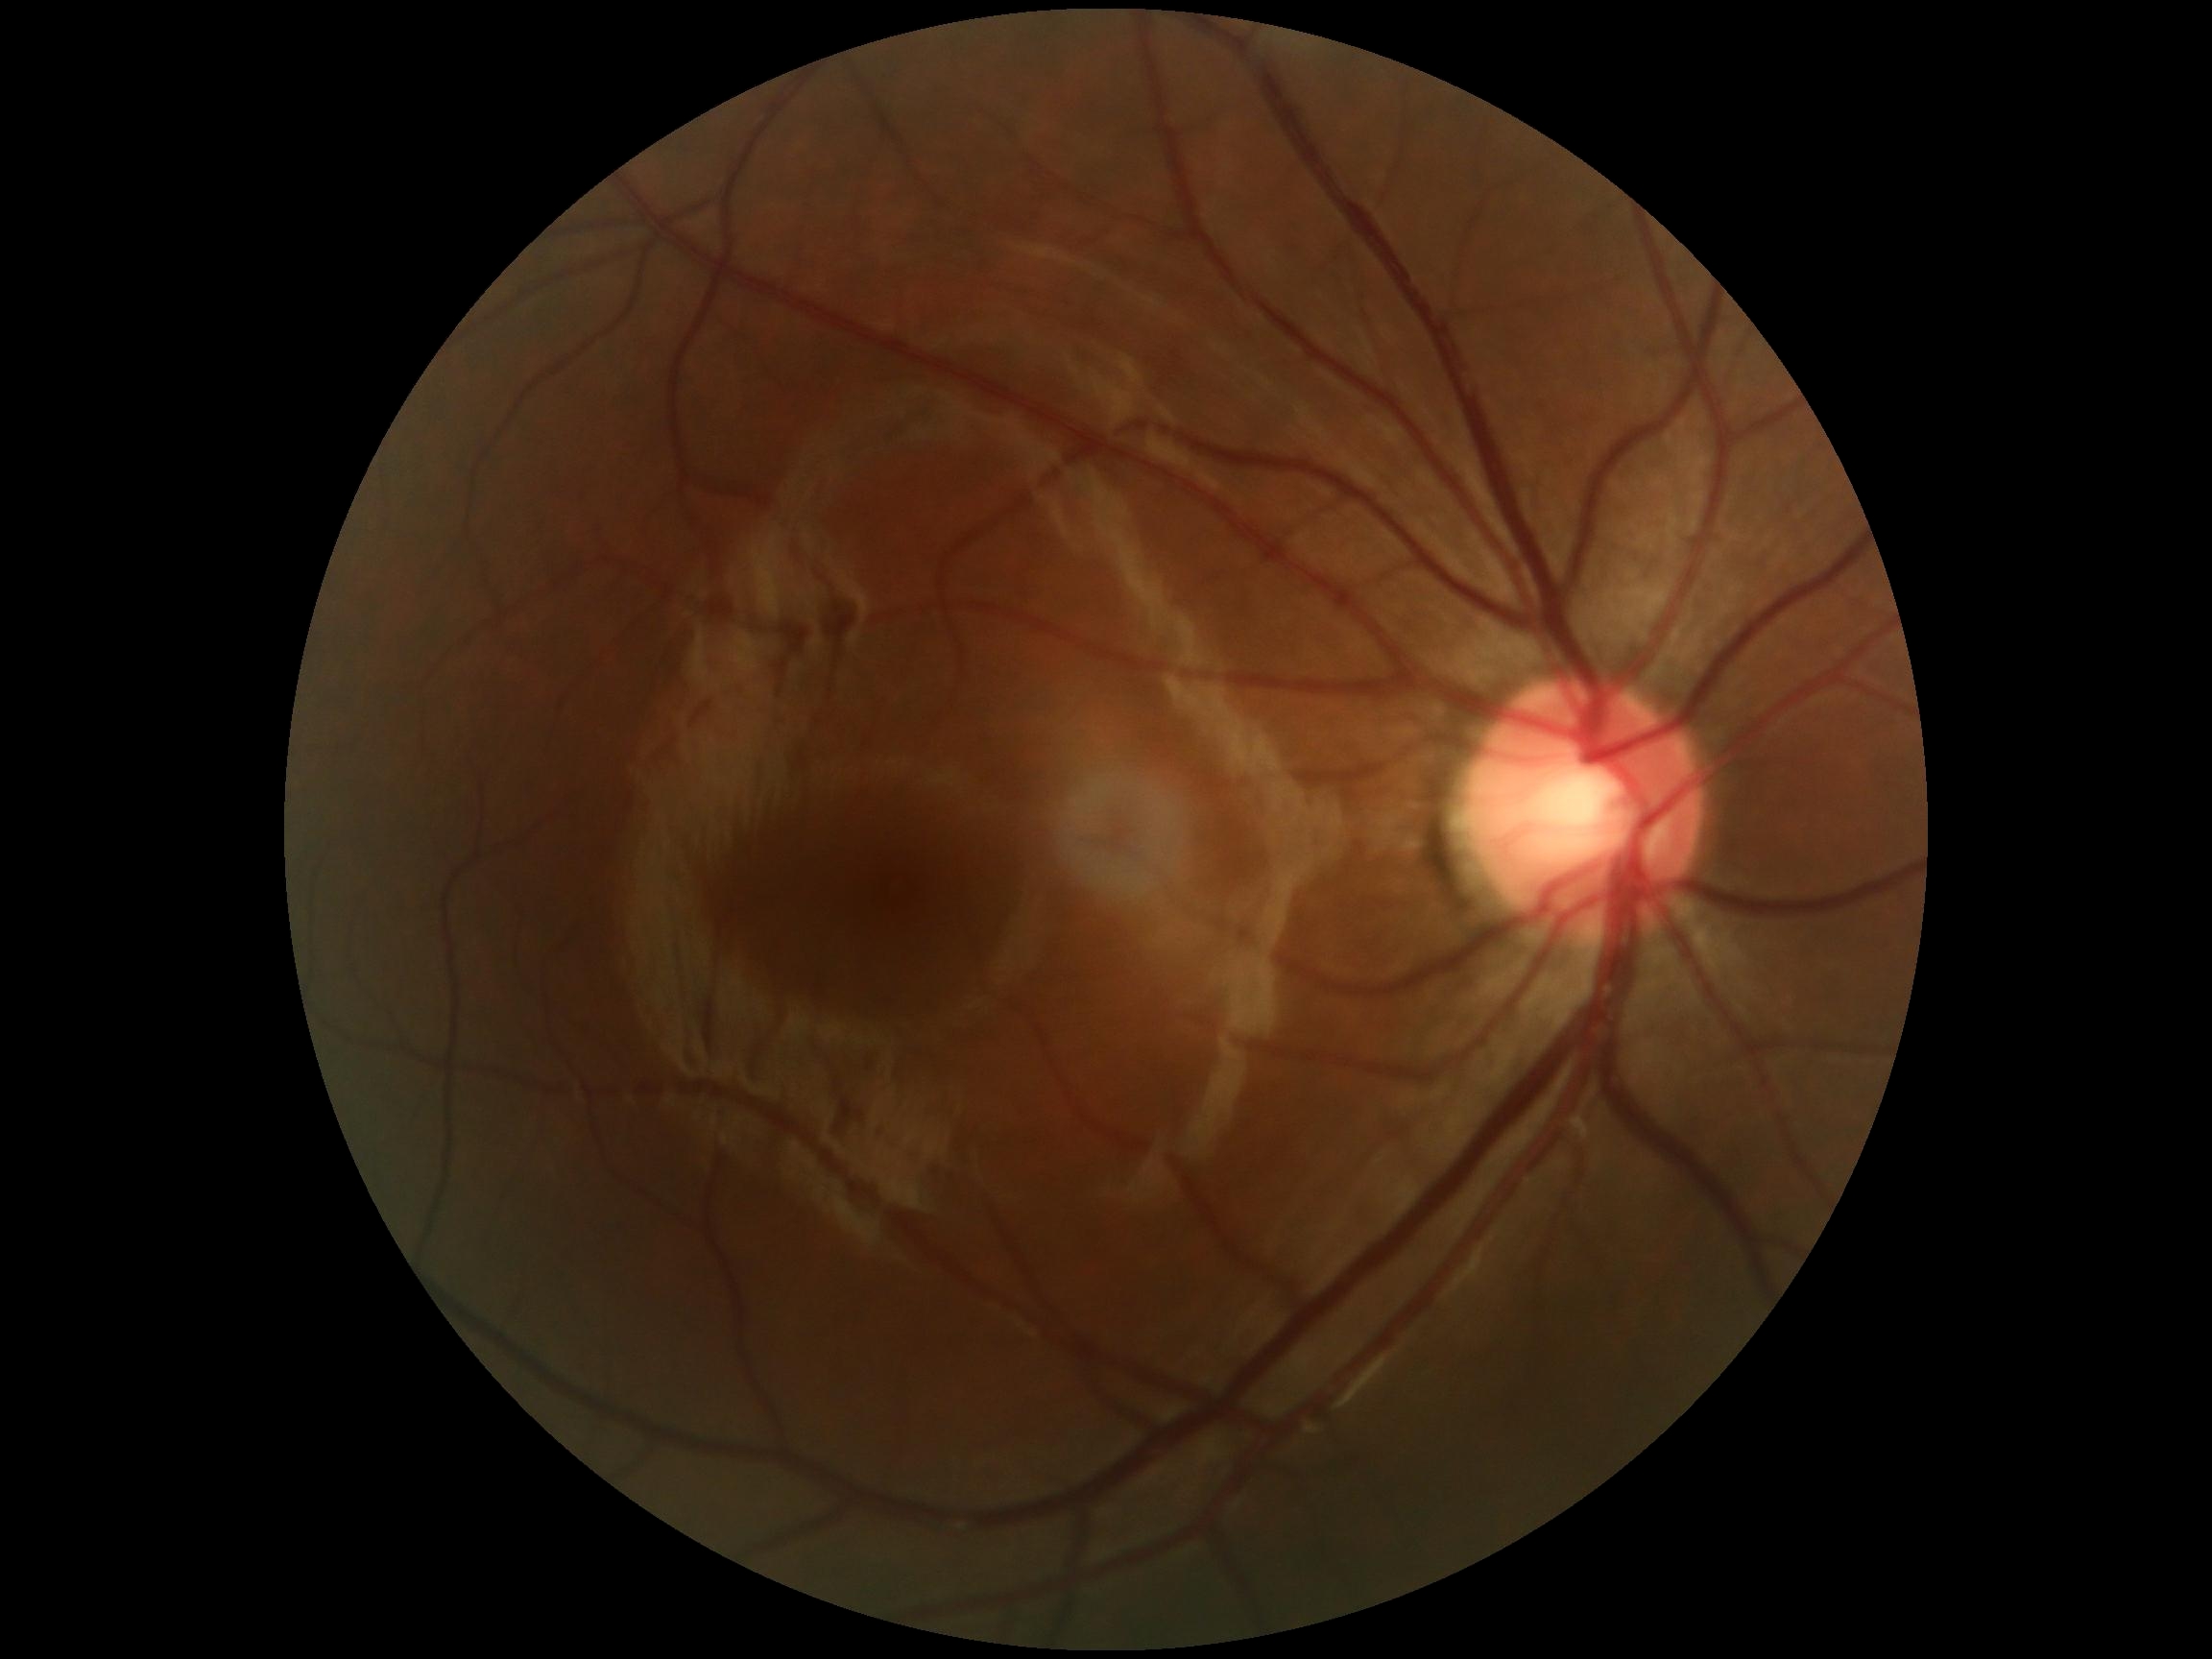
DR severity: 0/4.